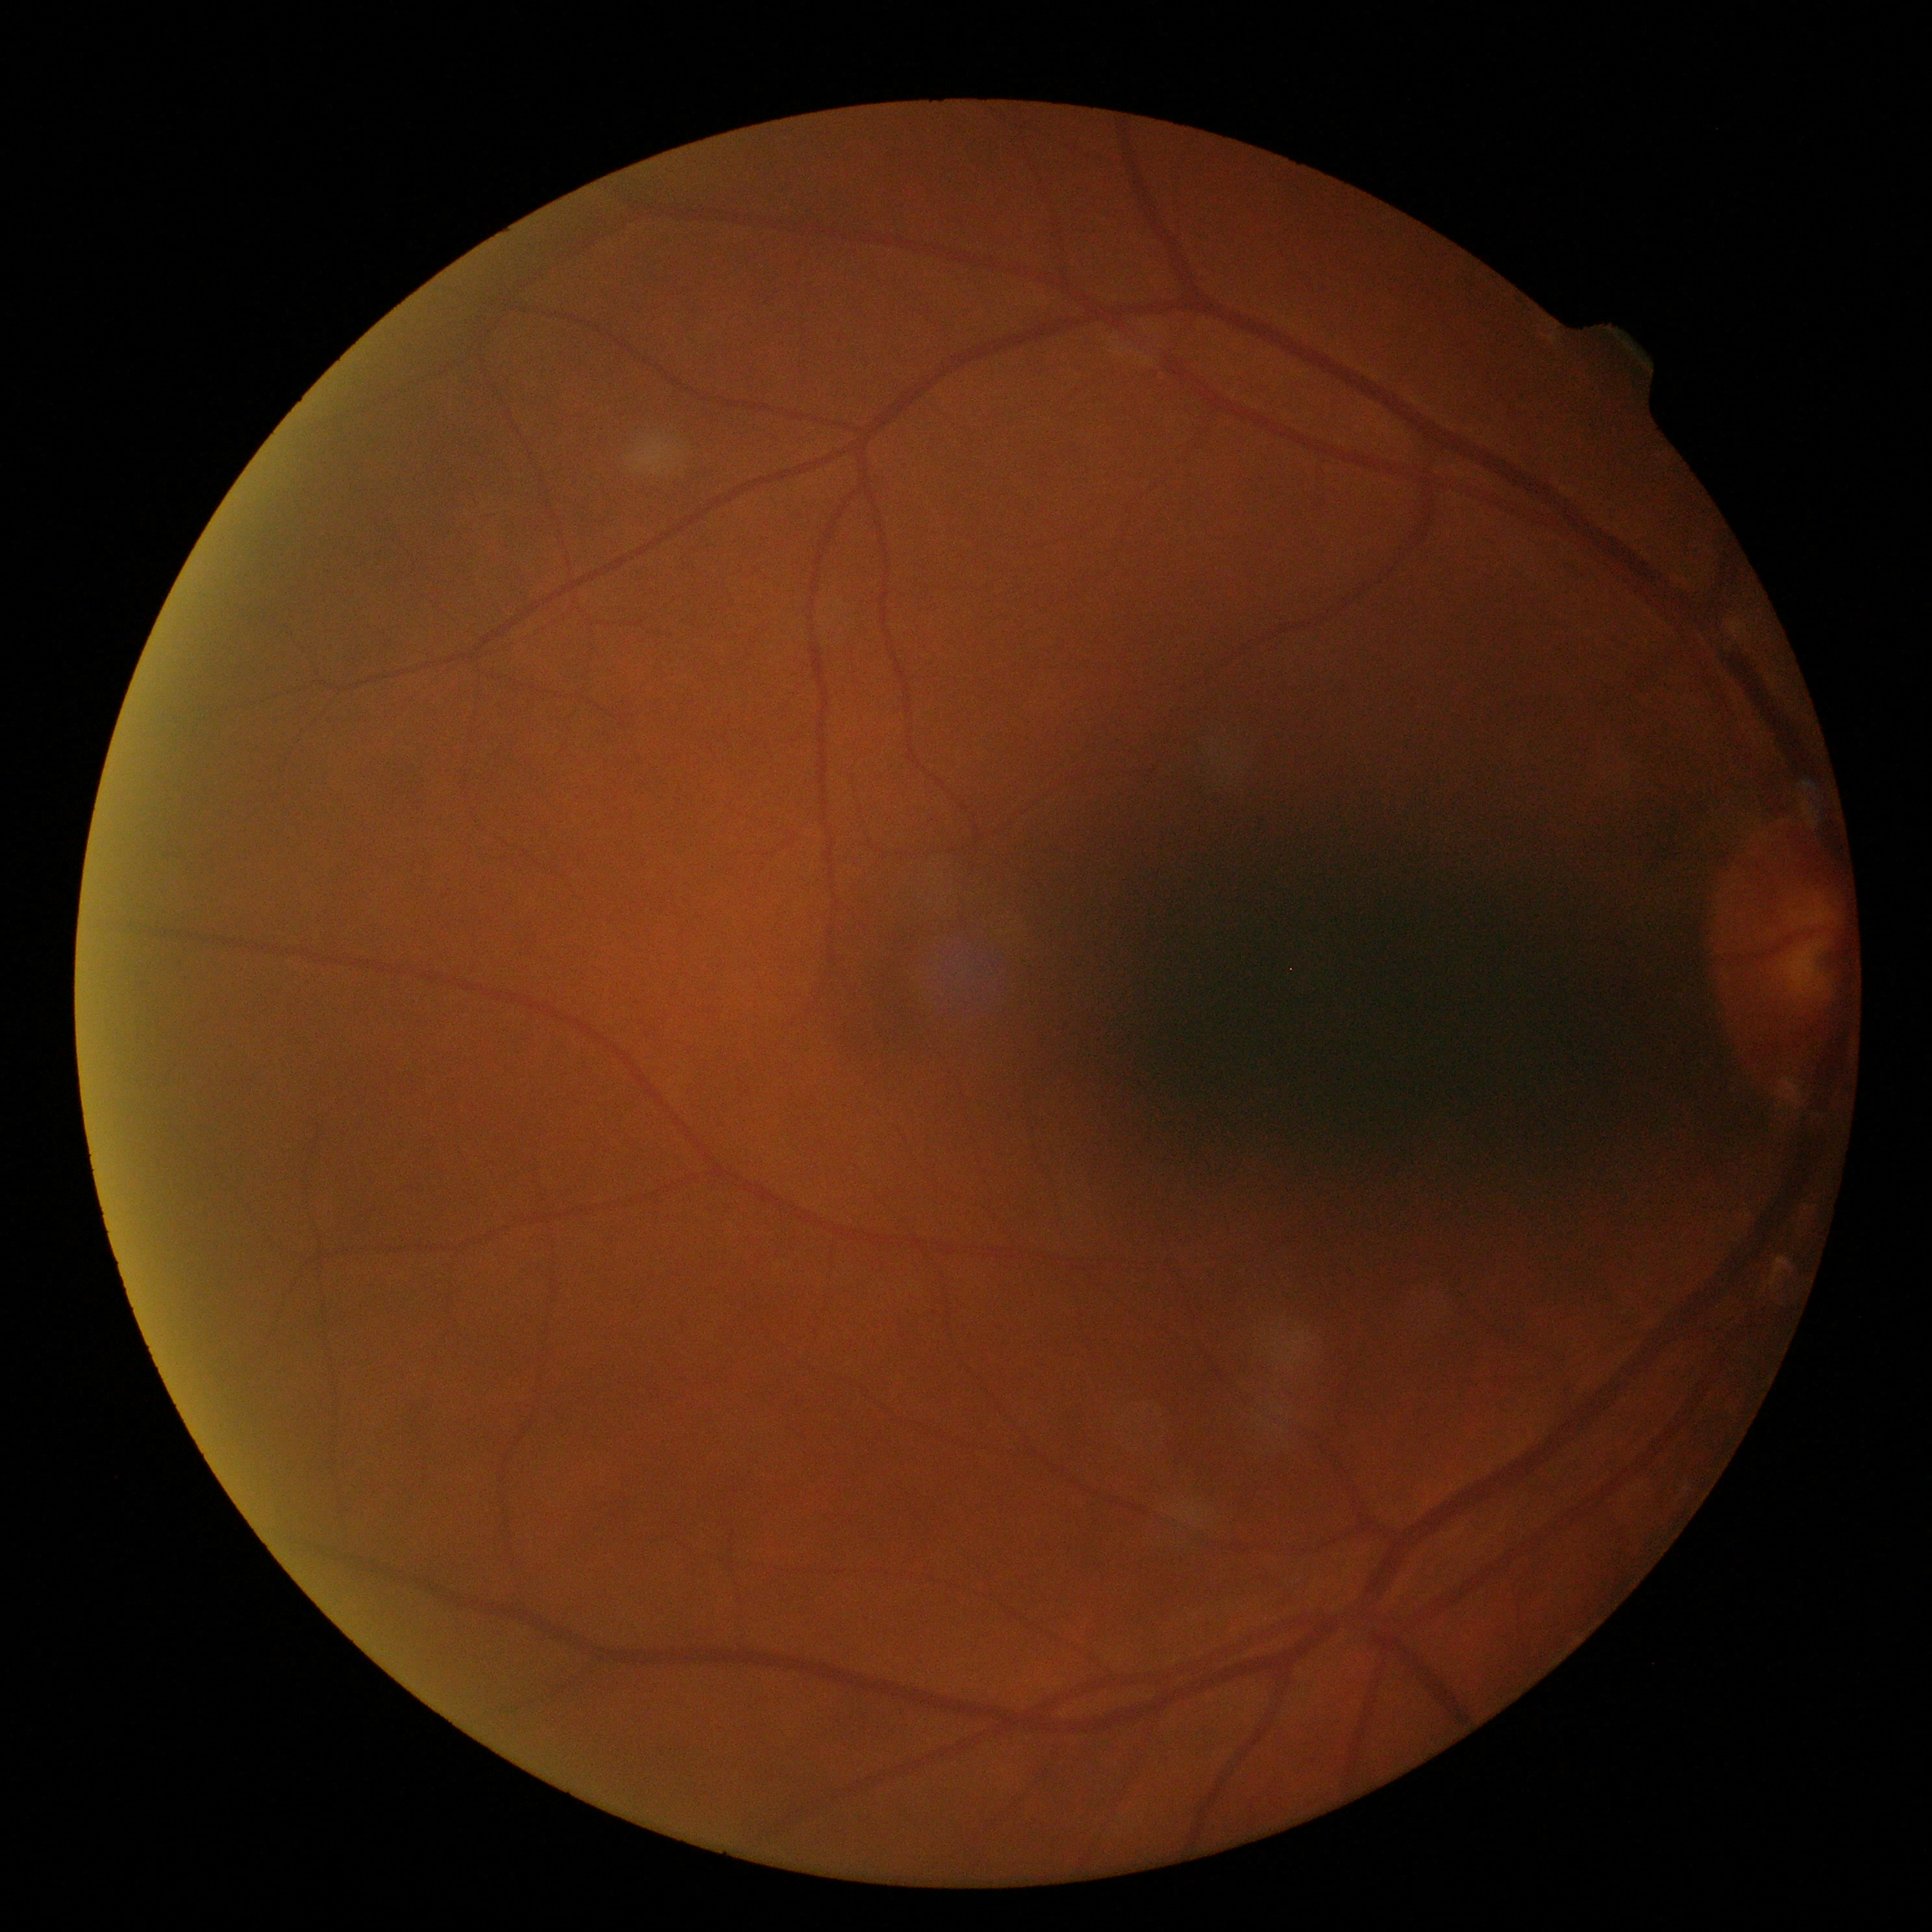
{"dr_grade": "grade 0 (no apparent retinopathy)"}